Wide-field contact fundus photograph of an infant
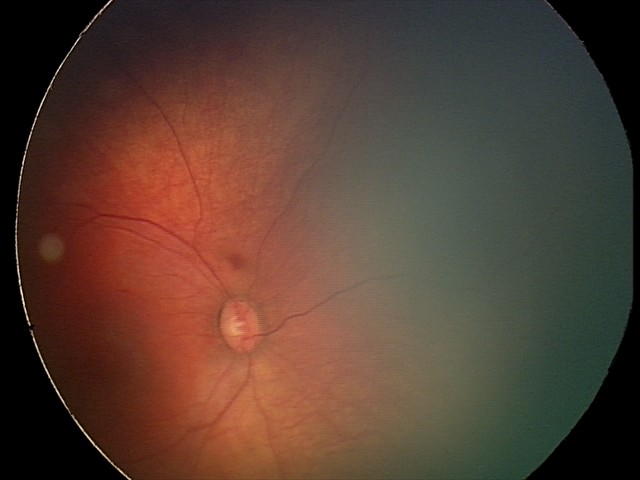
Q: What was the screening finding?
A: retinal hemorrhages